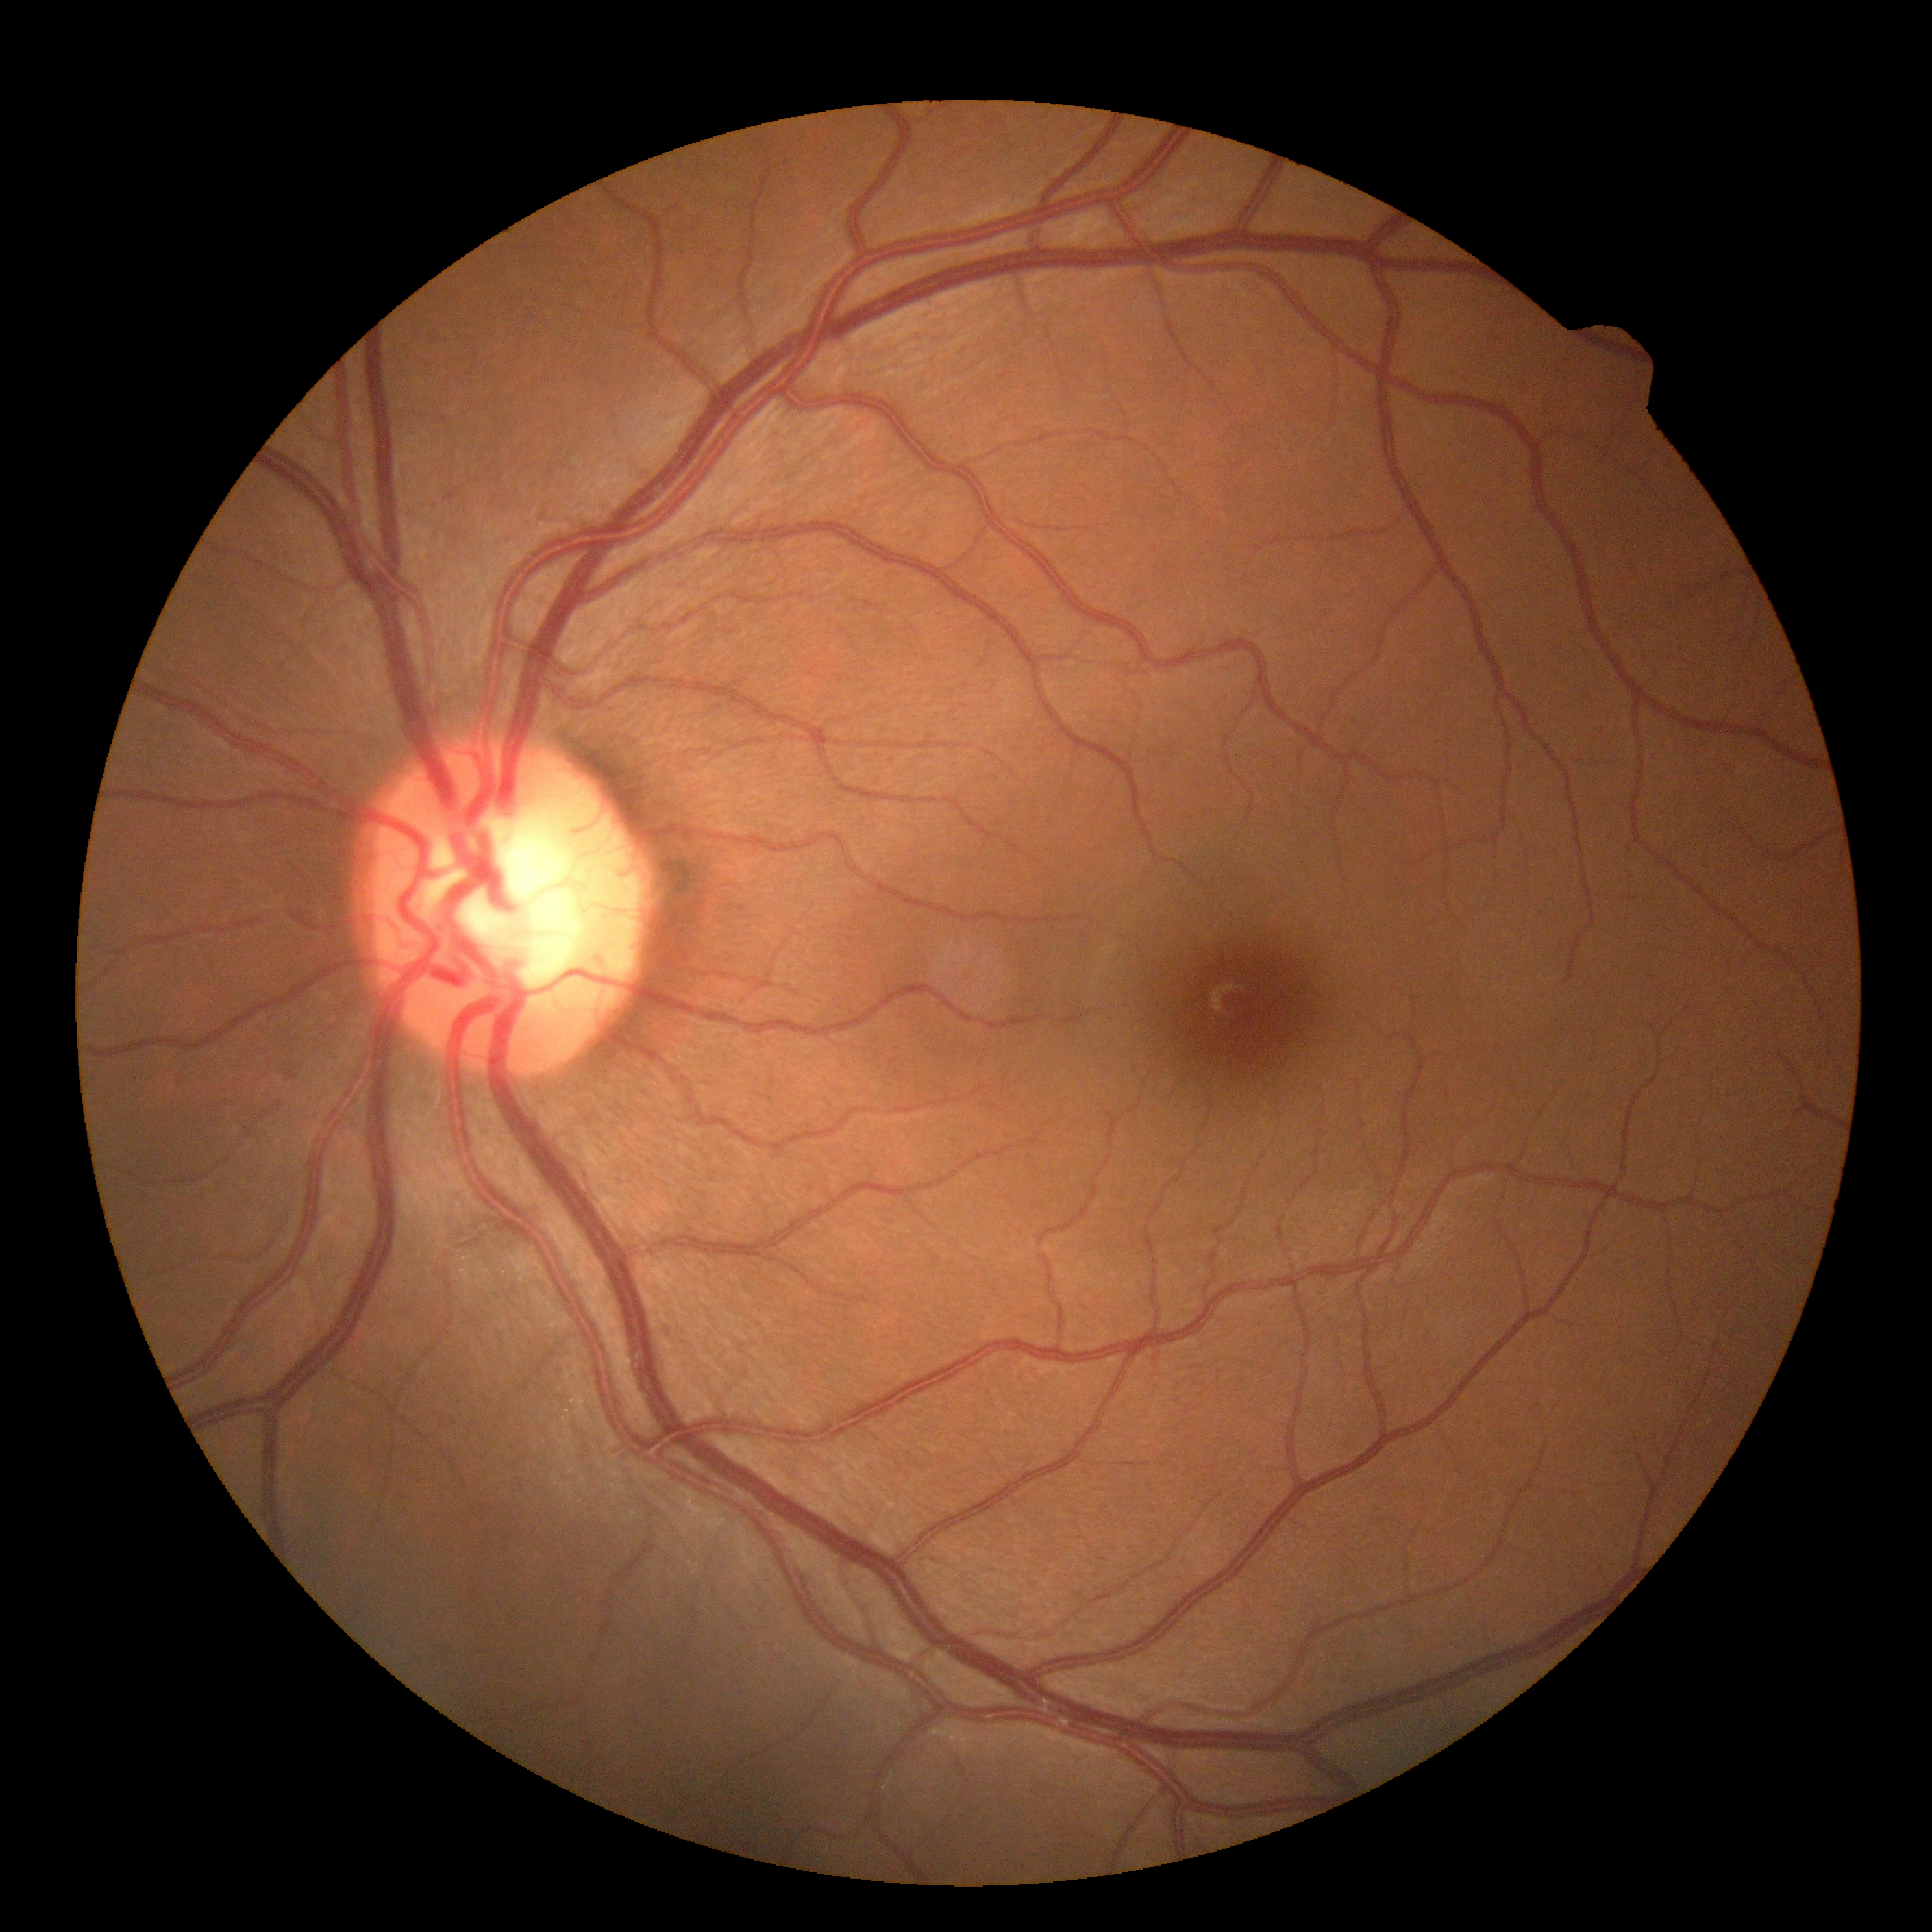
diabetic retinopathy grade: 0
DR impression: no apparent DR